Color fundus image, camera: NIDEK AFC-230
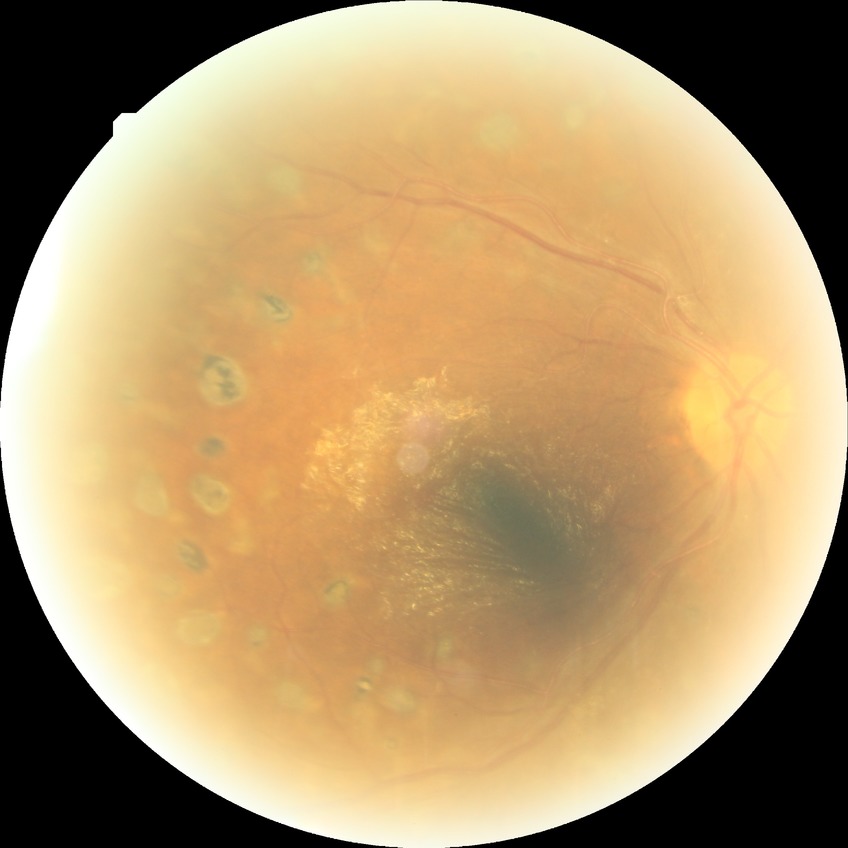 Davis stage is PDR.